DR severity per modified Davis staging — 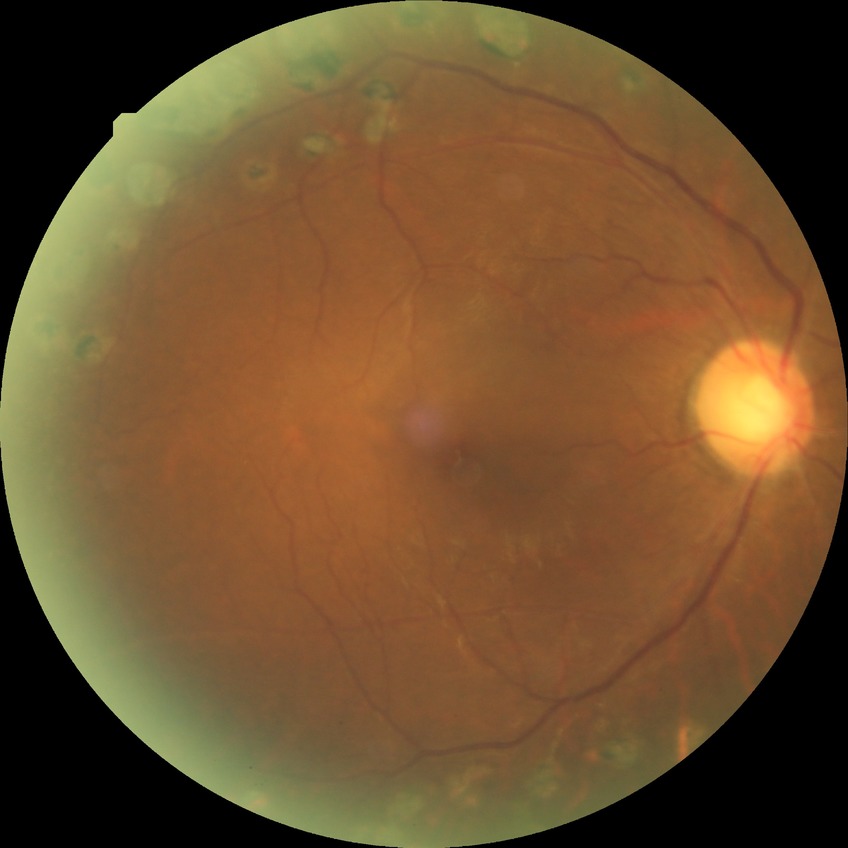

Diabetic retinopathy (DR): PDR (proliferative diabetic retinopathy).